Wide-field fundus image from infant ROP screening · 1440 x 1080 pixels — 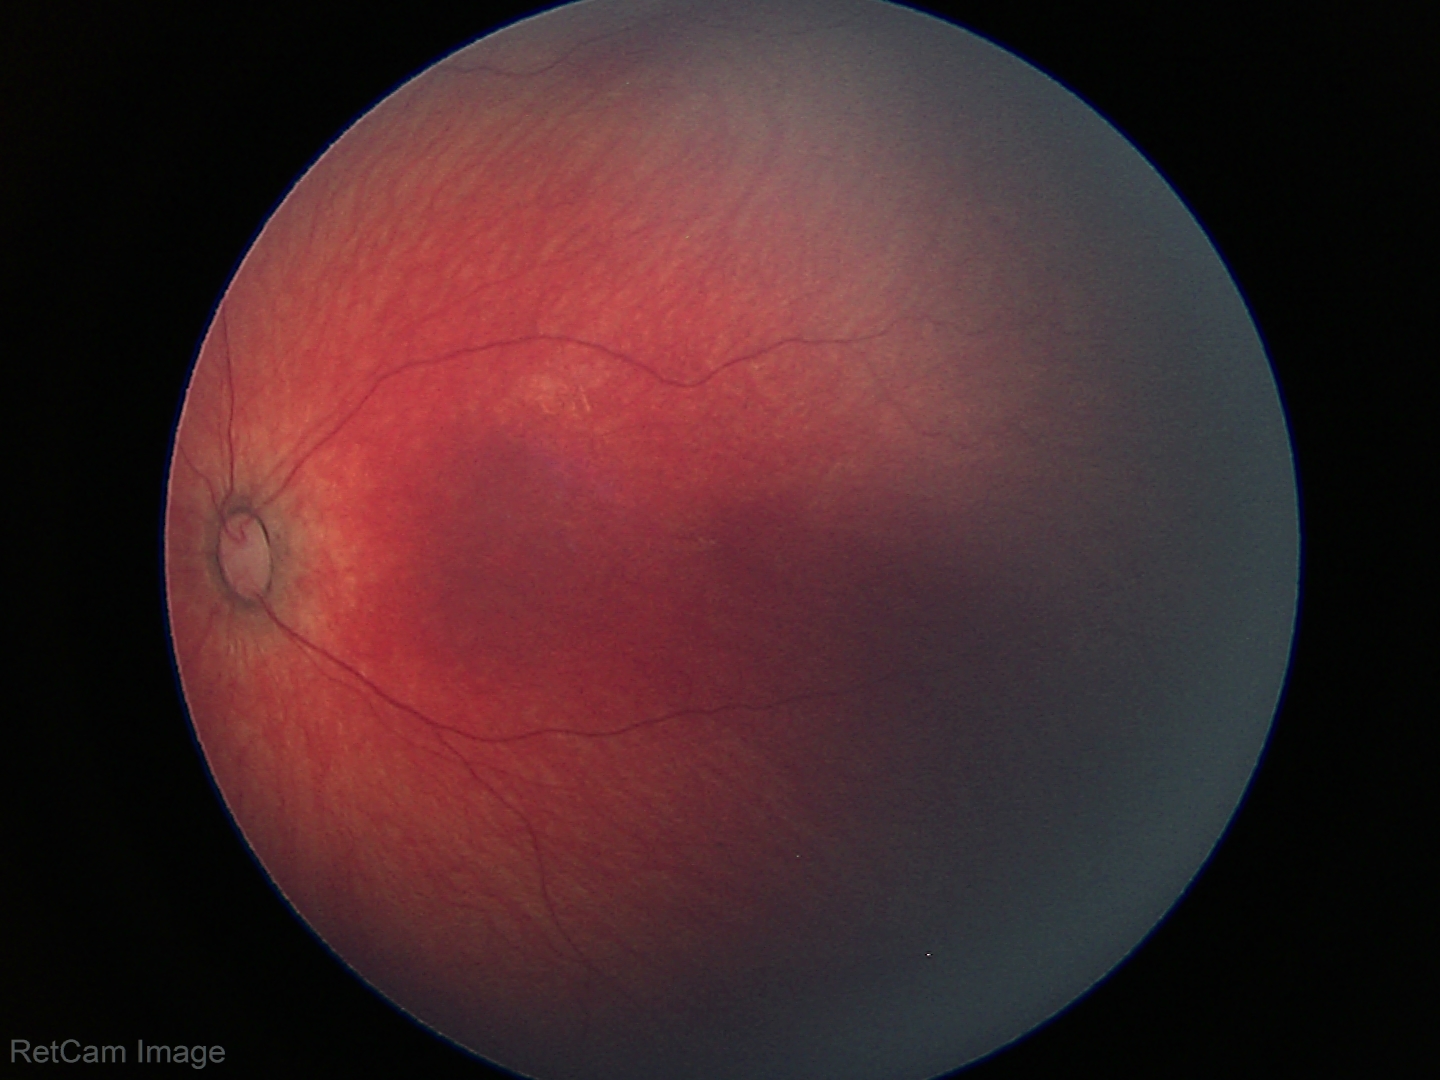 Screening examination diagnosed as physiological.